1725x1721px:
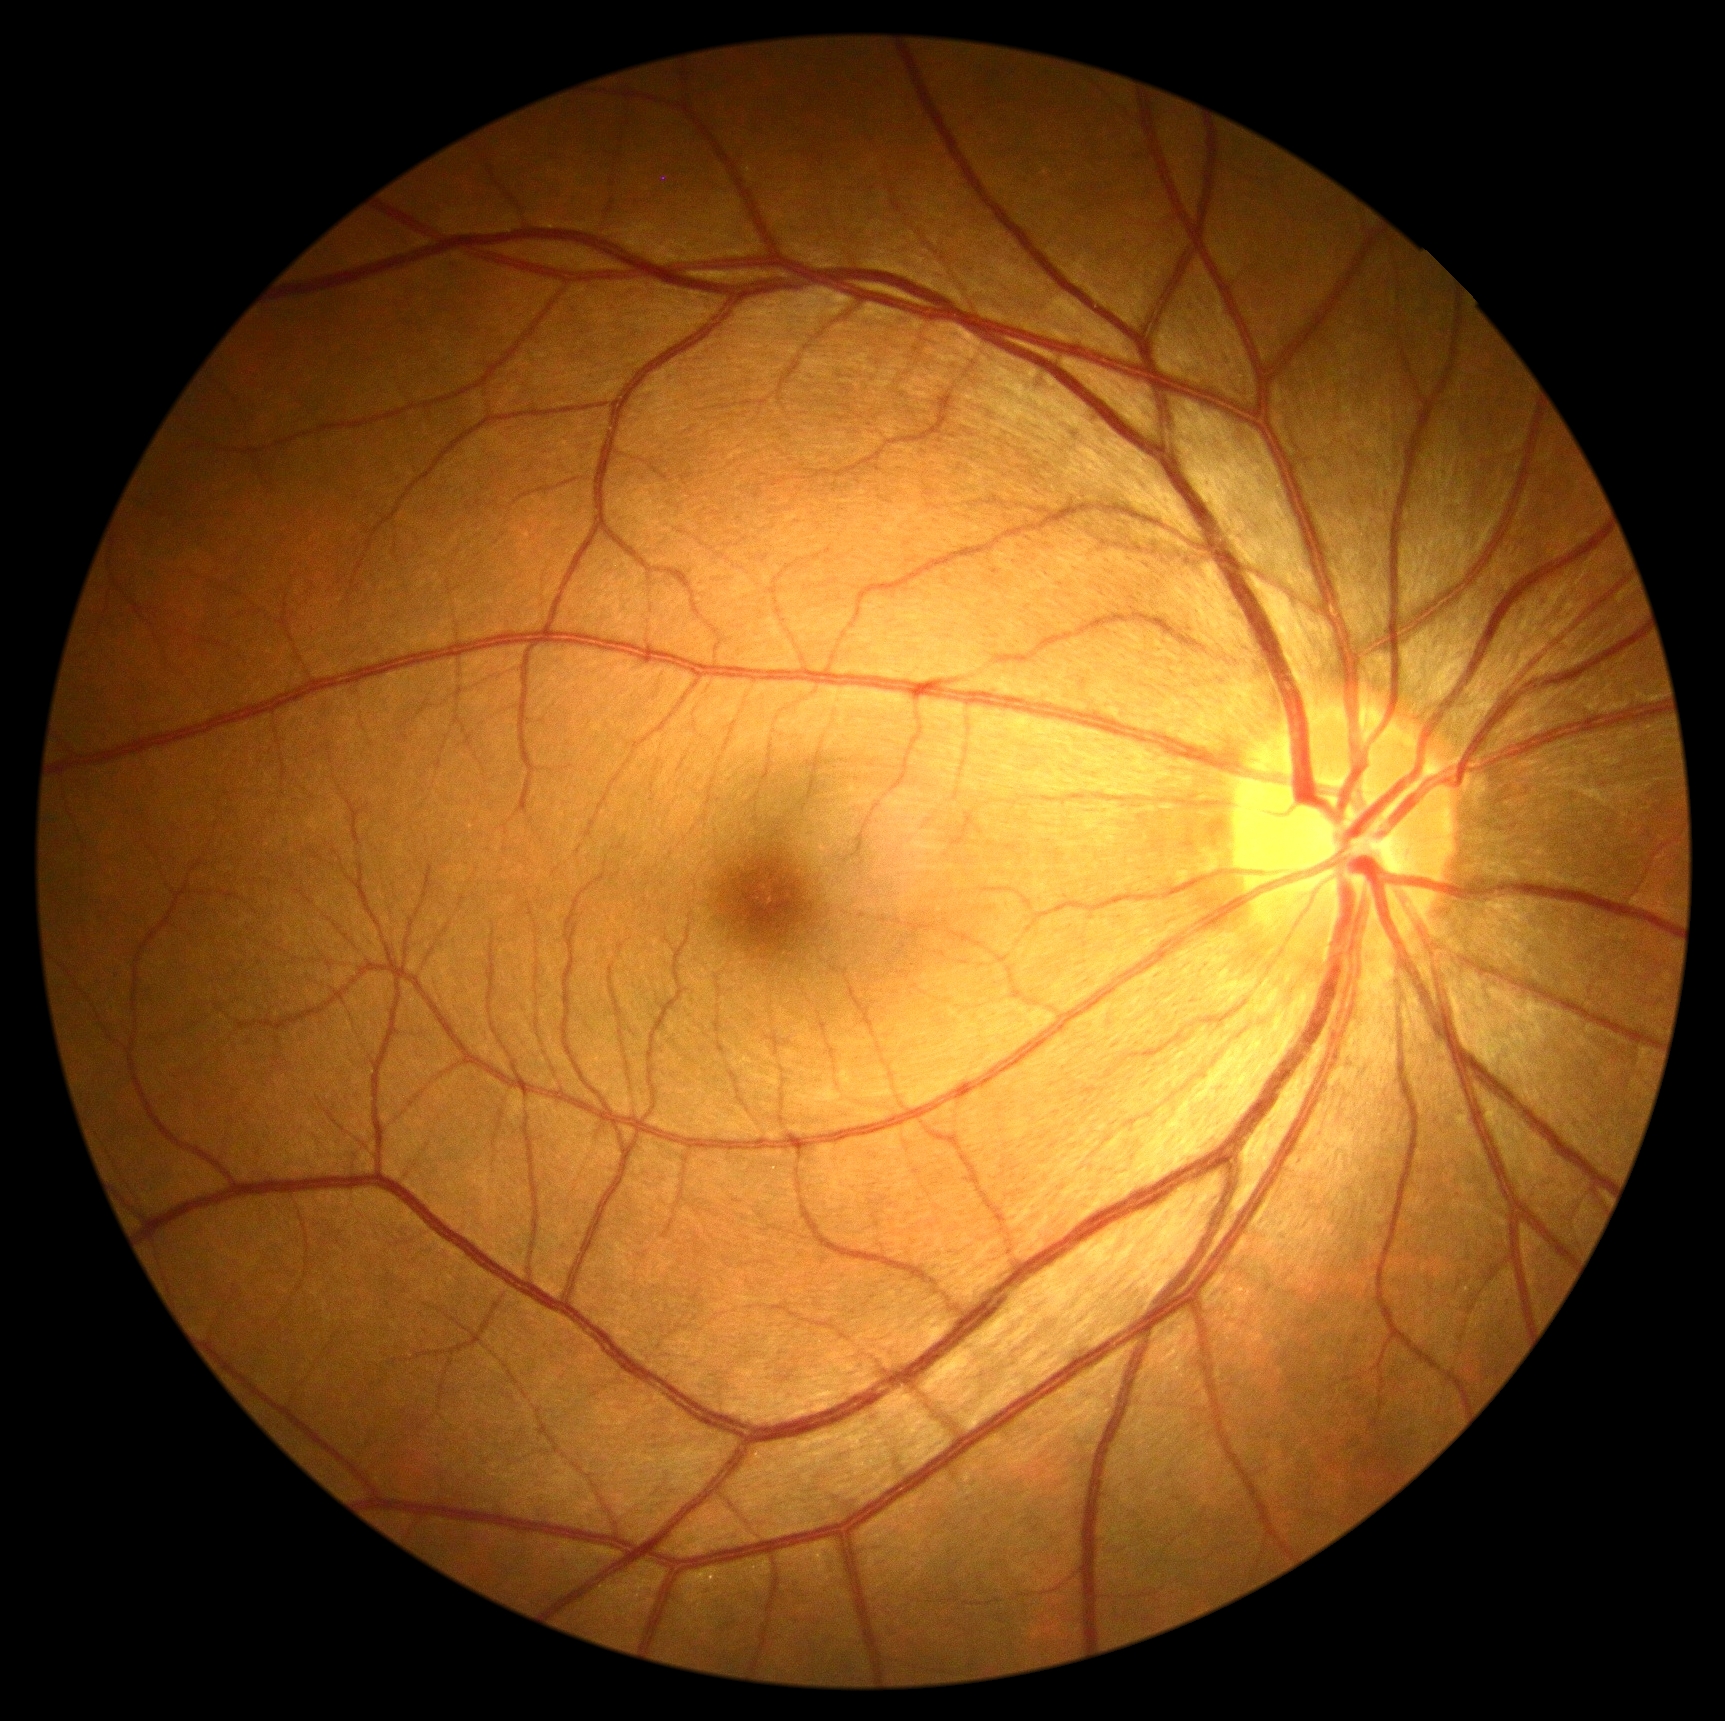 No signs of diabetic retinopathy.
DR severity is grade 0.